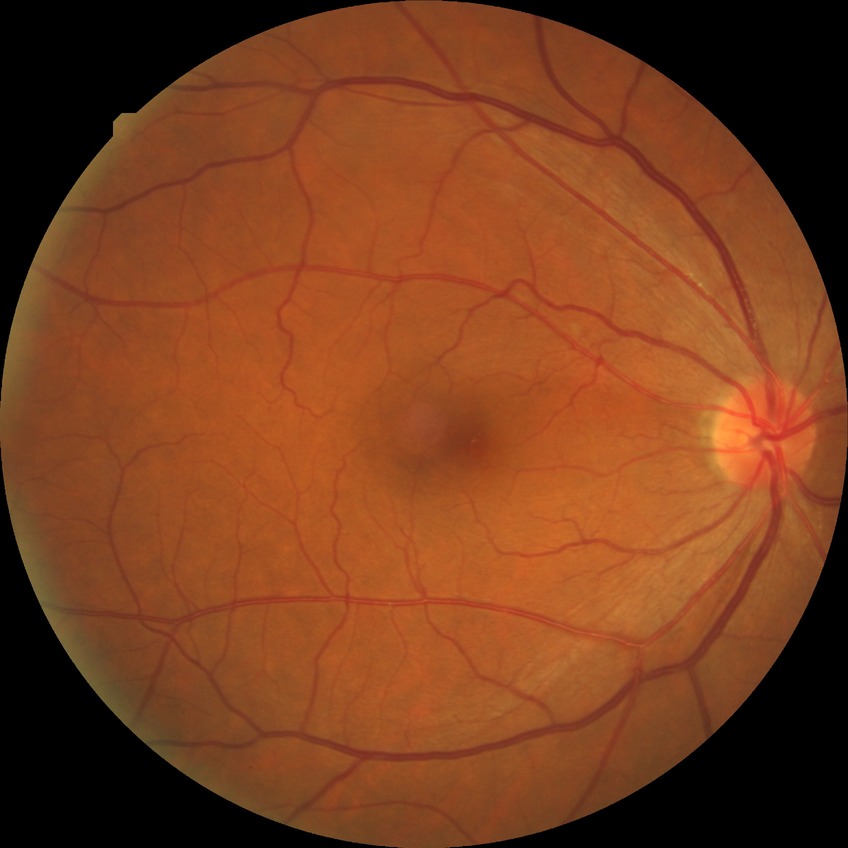 diabetic retinopathy (DR): NDR (no diabetic retinopathy)